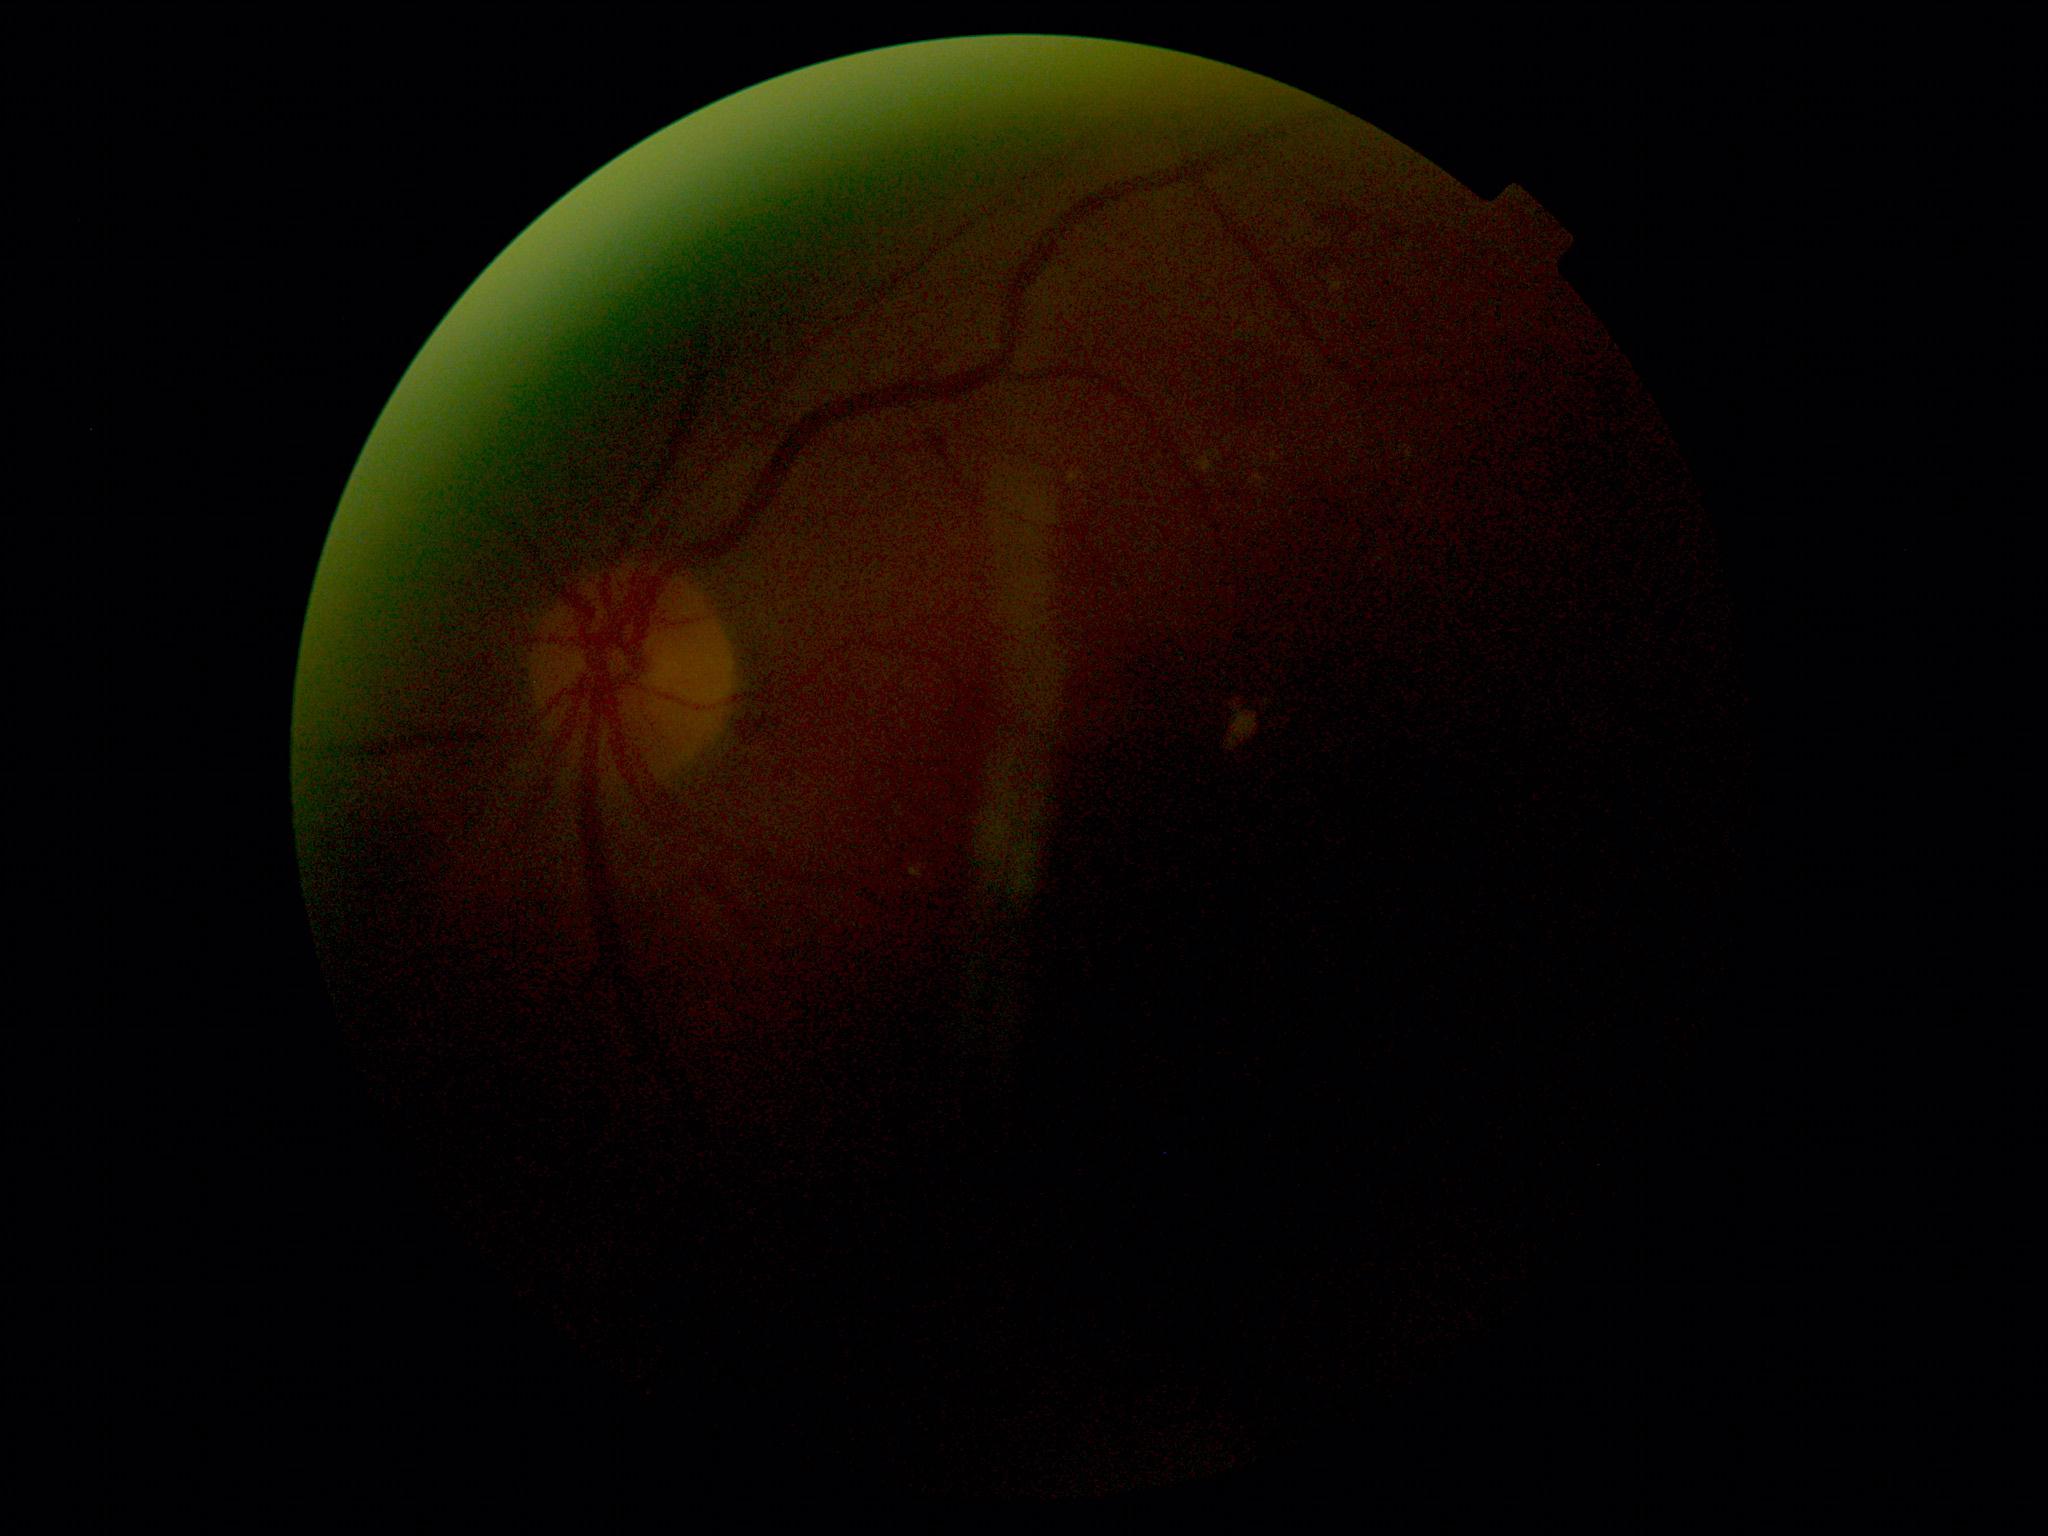
DR class: non-proliferative diabetic retinopathy. DR stage: grade 2 (moderate NPDR).